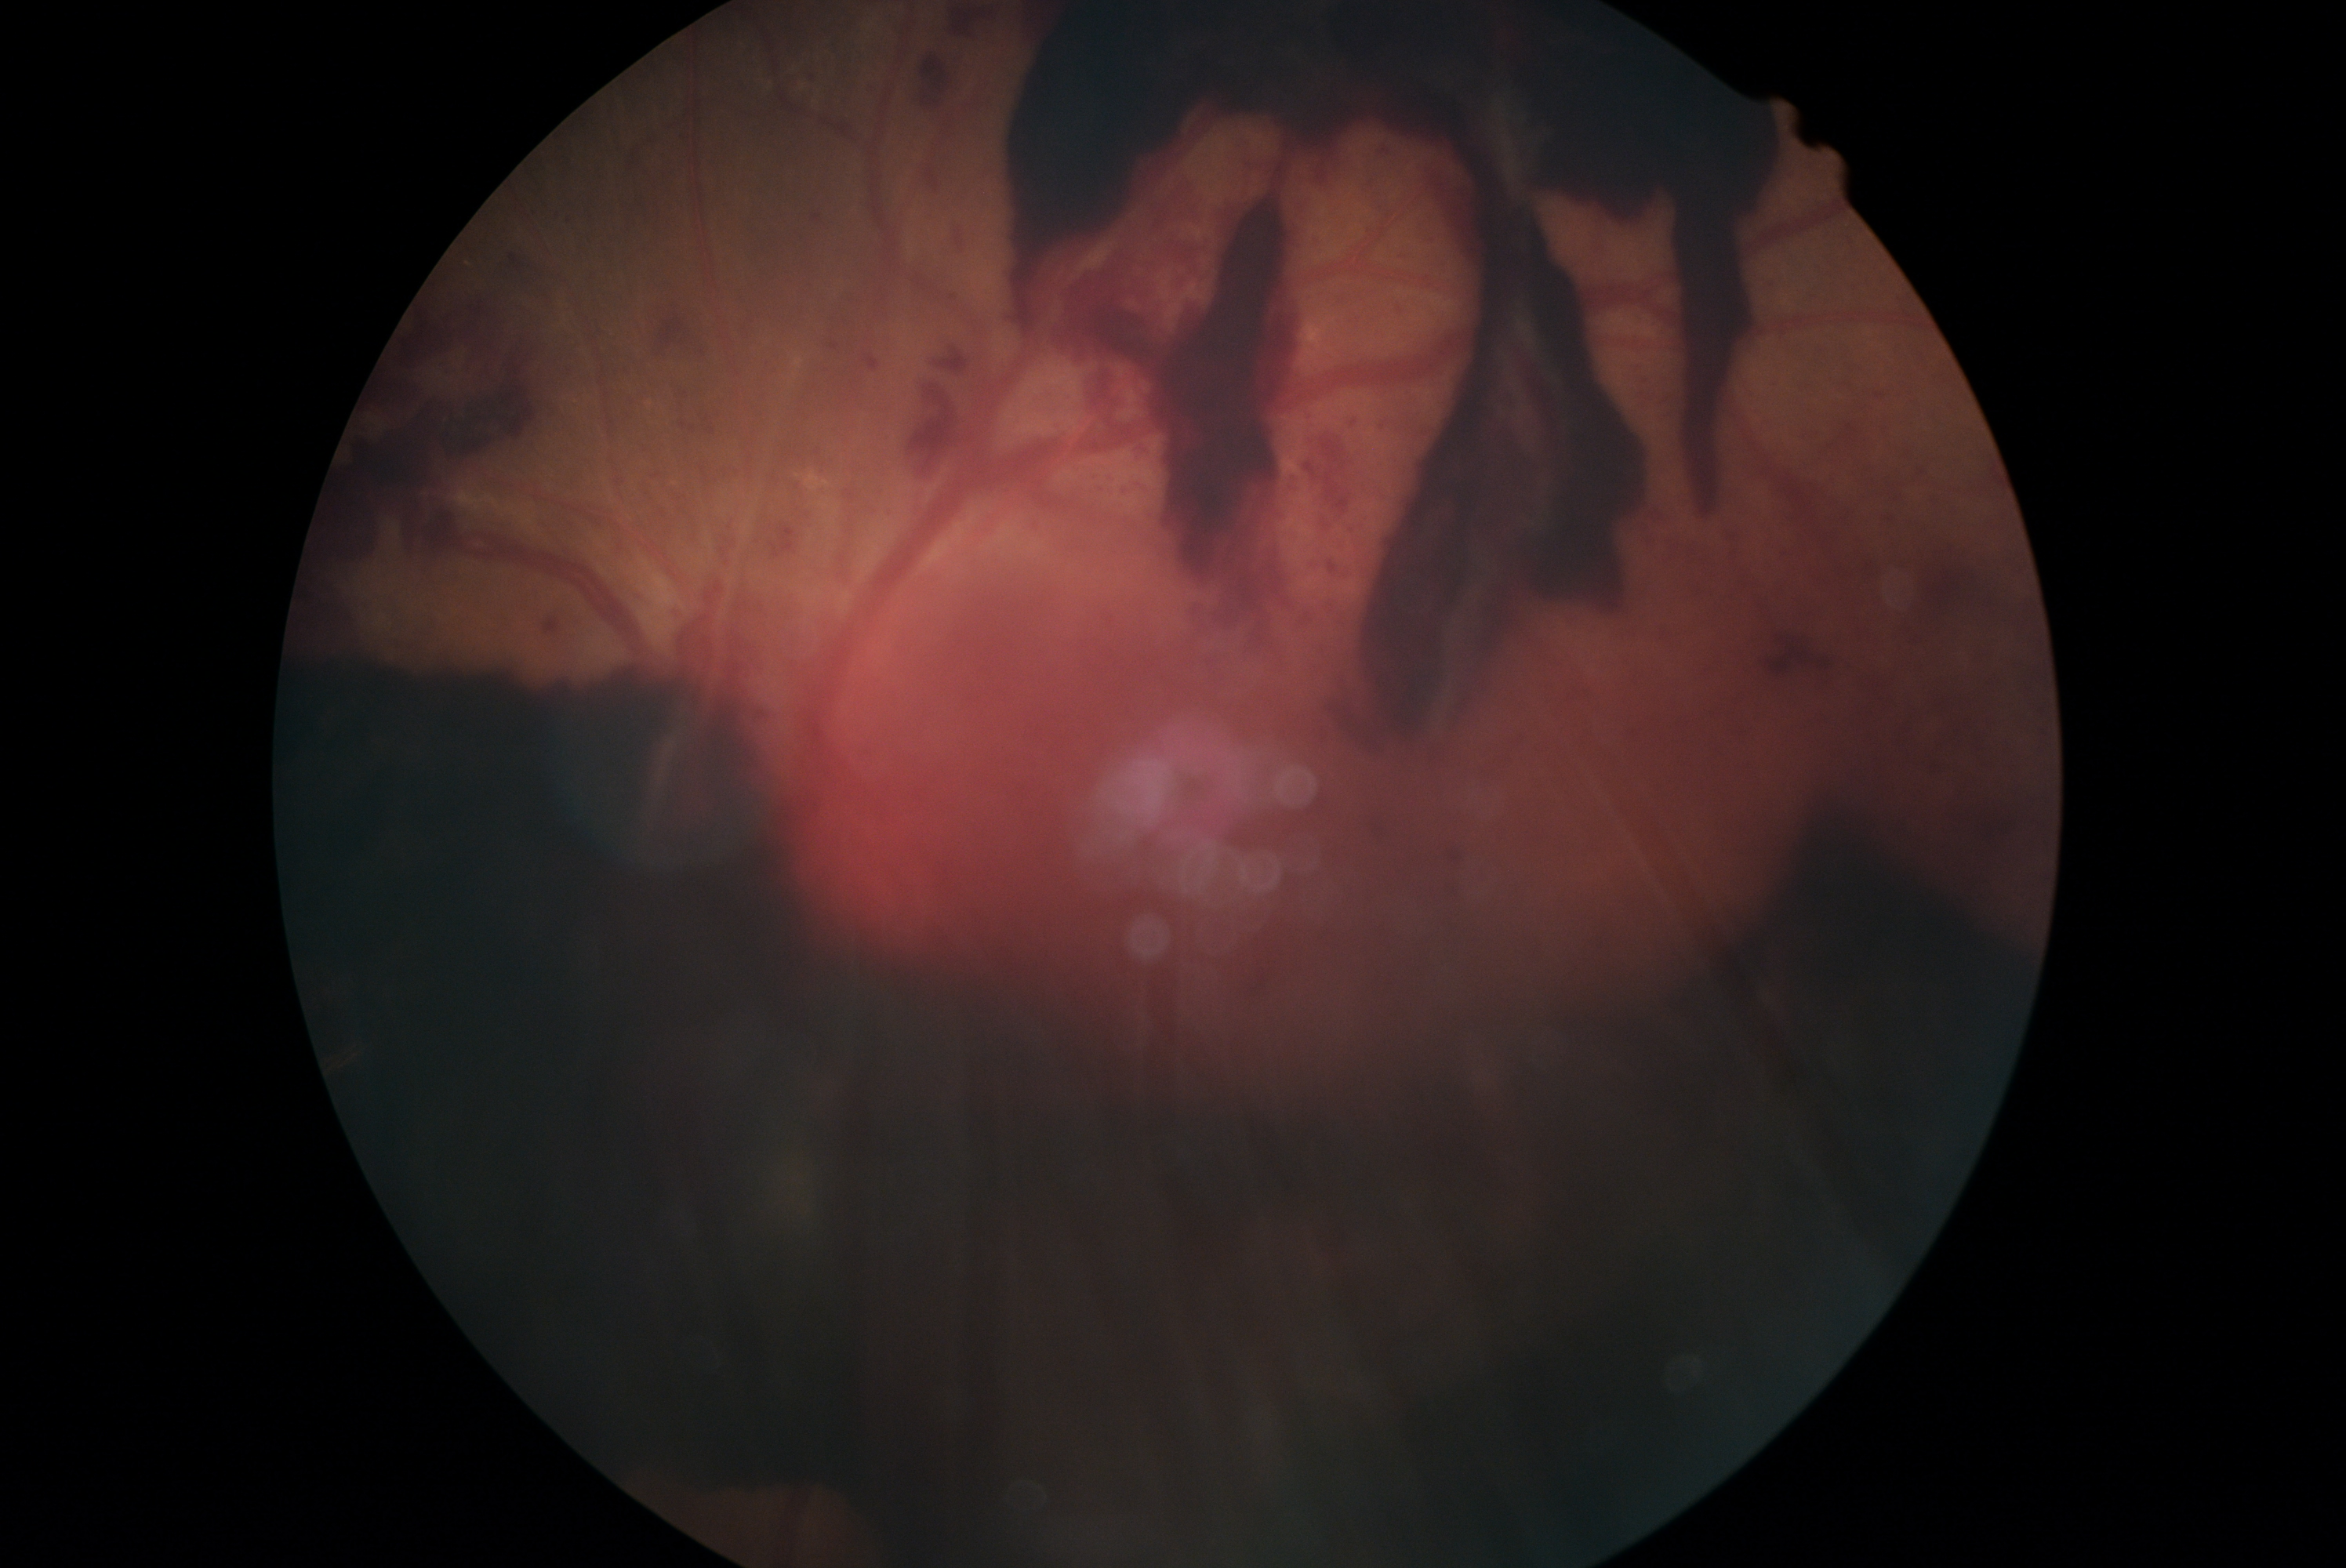
DR: grade 4.